DR severity per modified Davis staging — 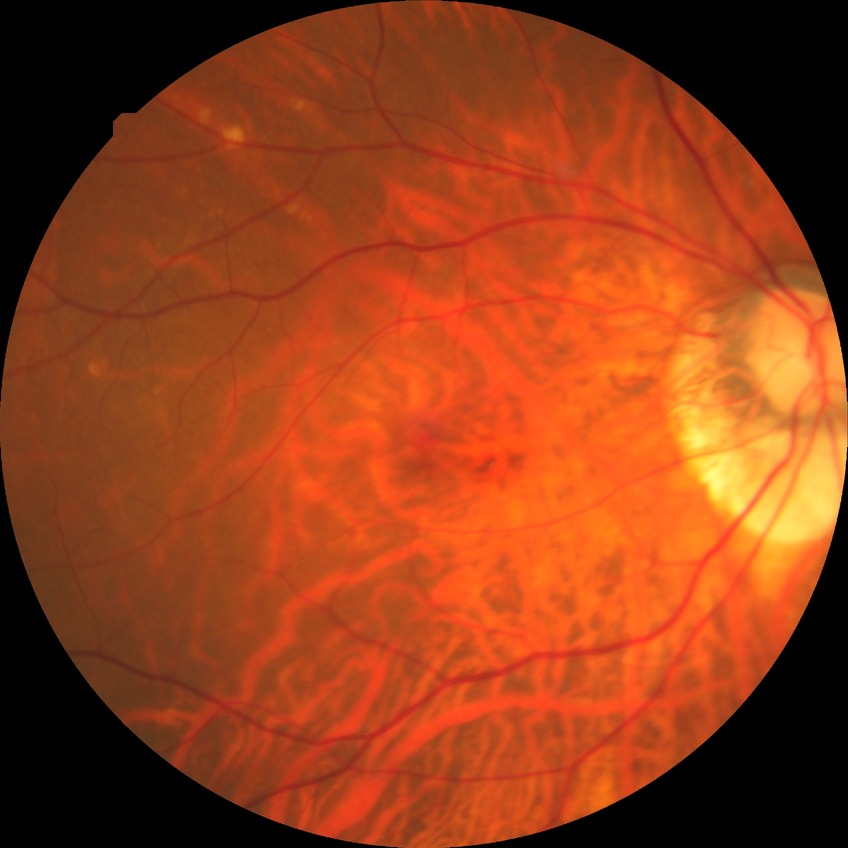 DR impression = no DR findings, modified Davis grade = NDR.